Pediatric retinal photograph (wide-field); Clarity RetCam 3, 130° FOV; 640 by 480 pixels.
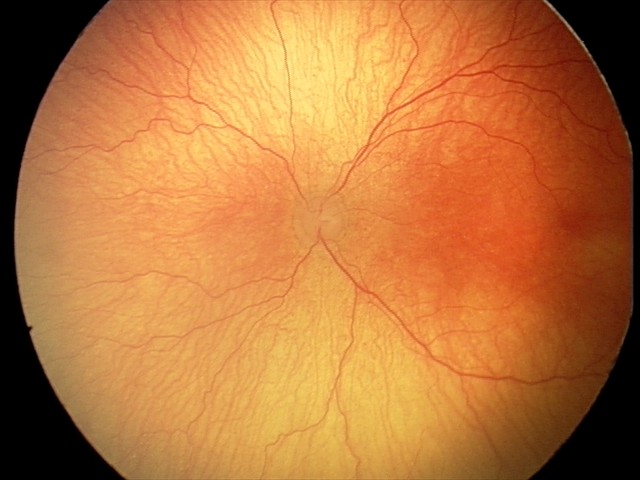 From an examination with diagnosis of aggressive retinopathy of prematurity — rapidly progressive severe ROP with prominent plus disease, often without classic stage progression. With plus disease.